Davis DR grading: 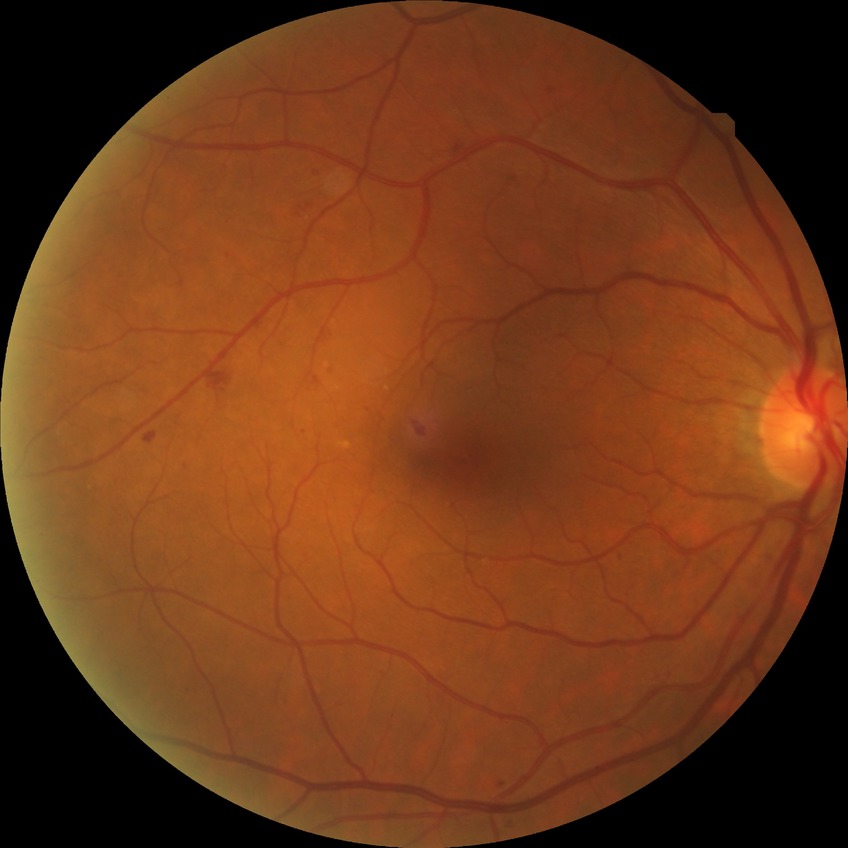 modified Davis grading = simple diabetic retinopathy, DR class = non-proliferative diabetic retinopathy.